CFP; 45-degree field of view: 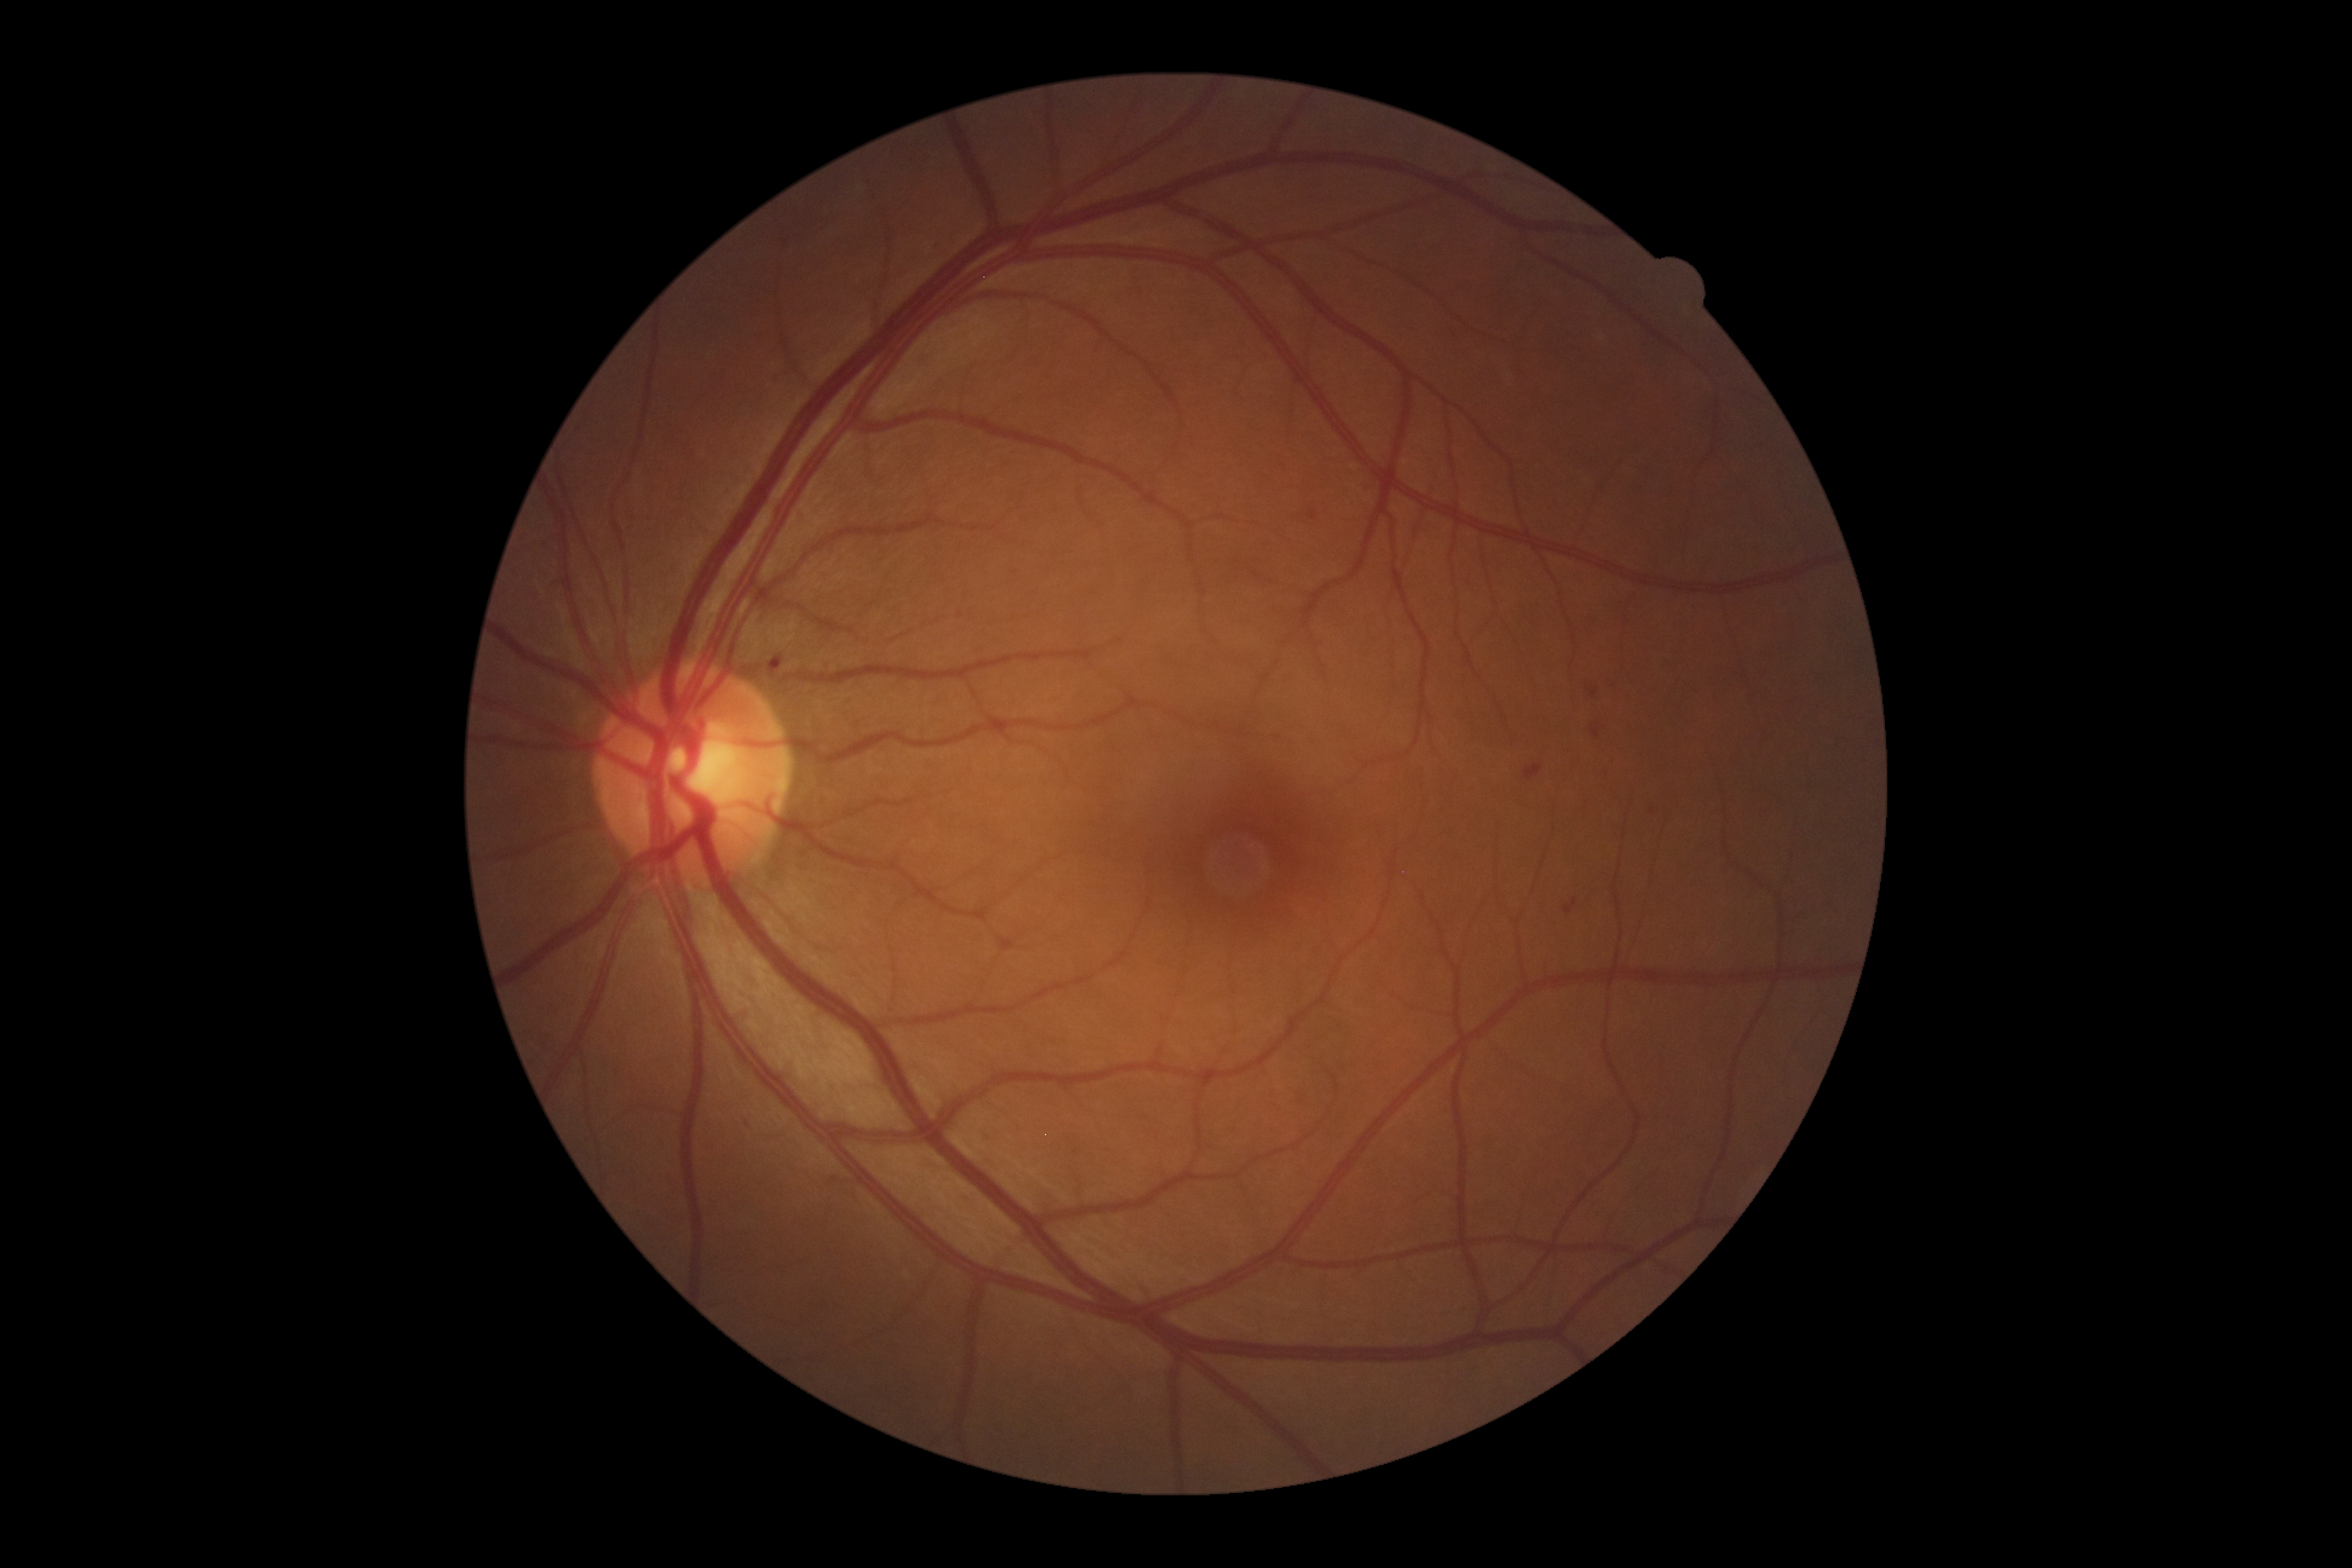

Diabetic retinopathy (DR): 2; non-proliferative diabetic retinopathy
soft exudates (SEs): not present
hemorrhages (HEs): [left=1588, top=687, right=1599, bottom=696]; [left=1564, top=900, right=1578, bottom=914]; [left=1524, top=764, right=1543, bottom=781]; [left=1590, top=724, right=1601, bottom=740]; [left=770, top=649, right=788, bottom=671]
hard exudates (EXs): not present
microaneurysms (MAs): [left=802, top=846, right=817, bottom=854]; [left=1310, top=509, right=1319, bottom=520]
MAs (small, approximate centers) near 1652, 812; 748, 1125